DR severity per modified Davis staging; color fundus photograph; 848x848; camera: NIDEK AFC-230
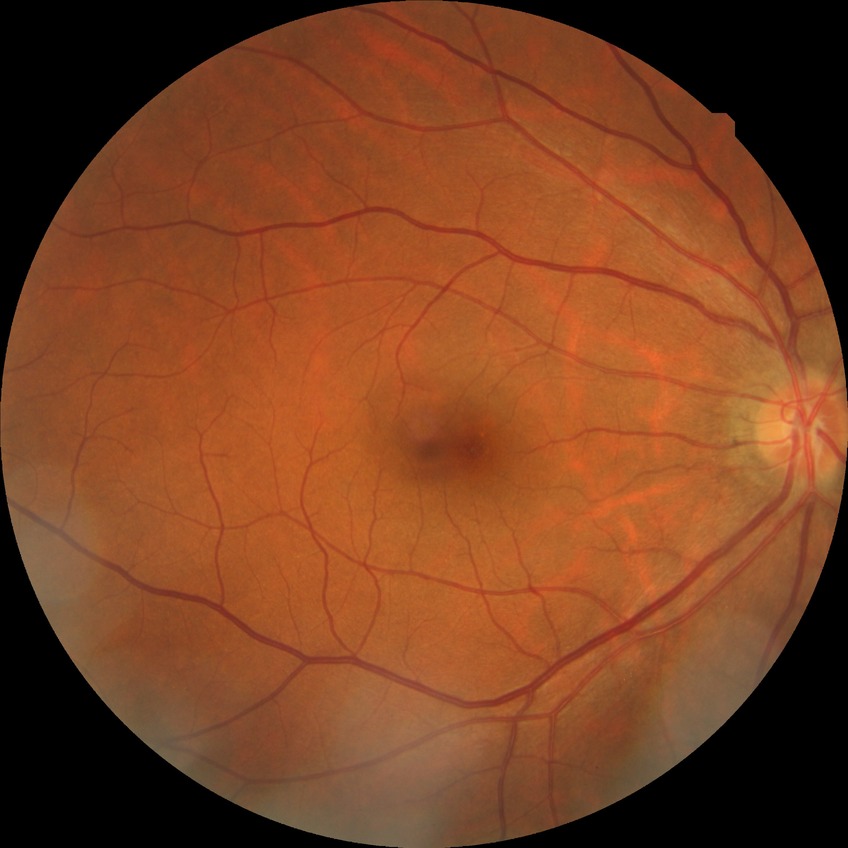

Diabetic retinopathy (DR): no diabetic retinopathy (NDR).